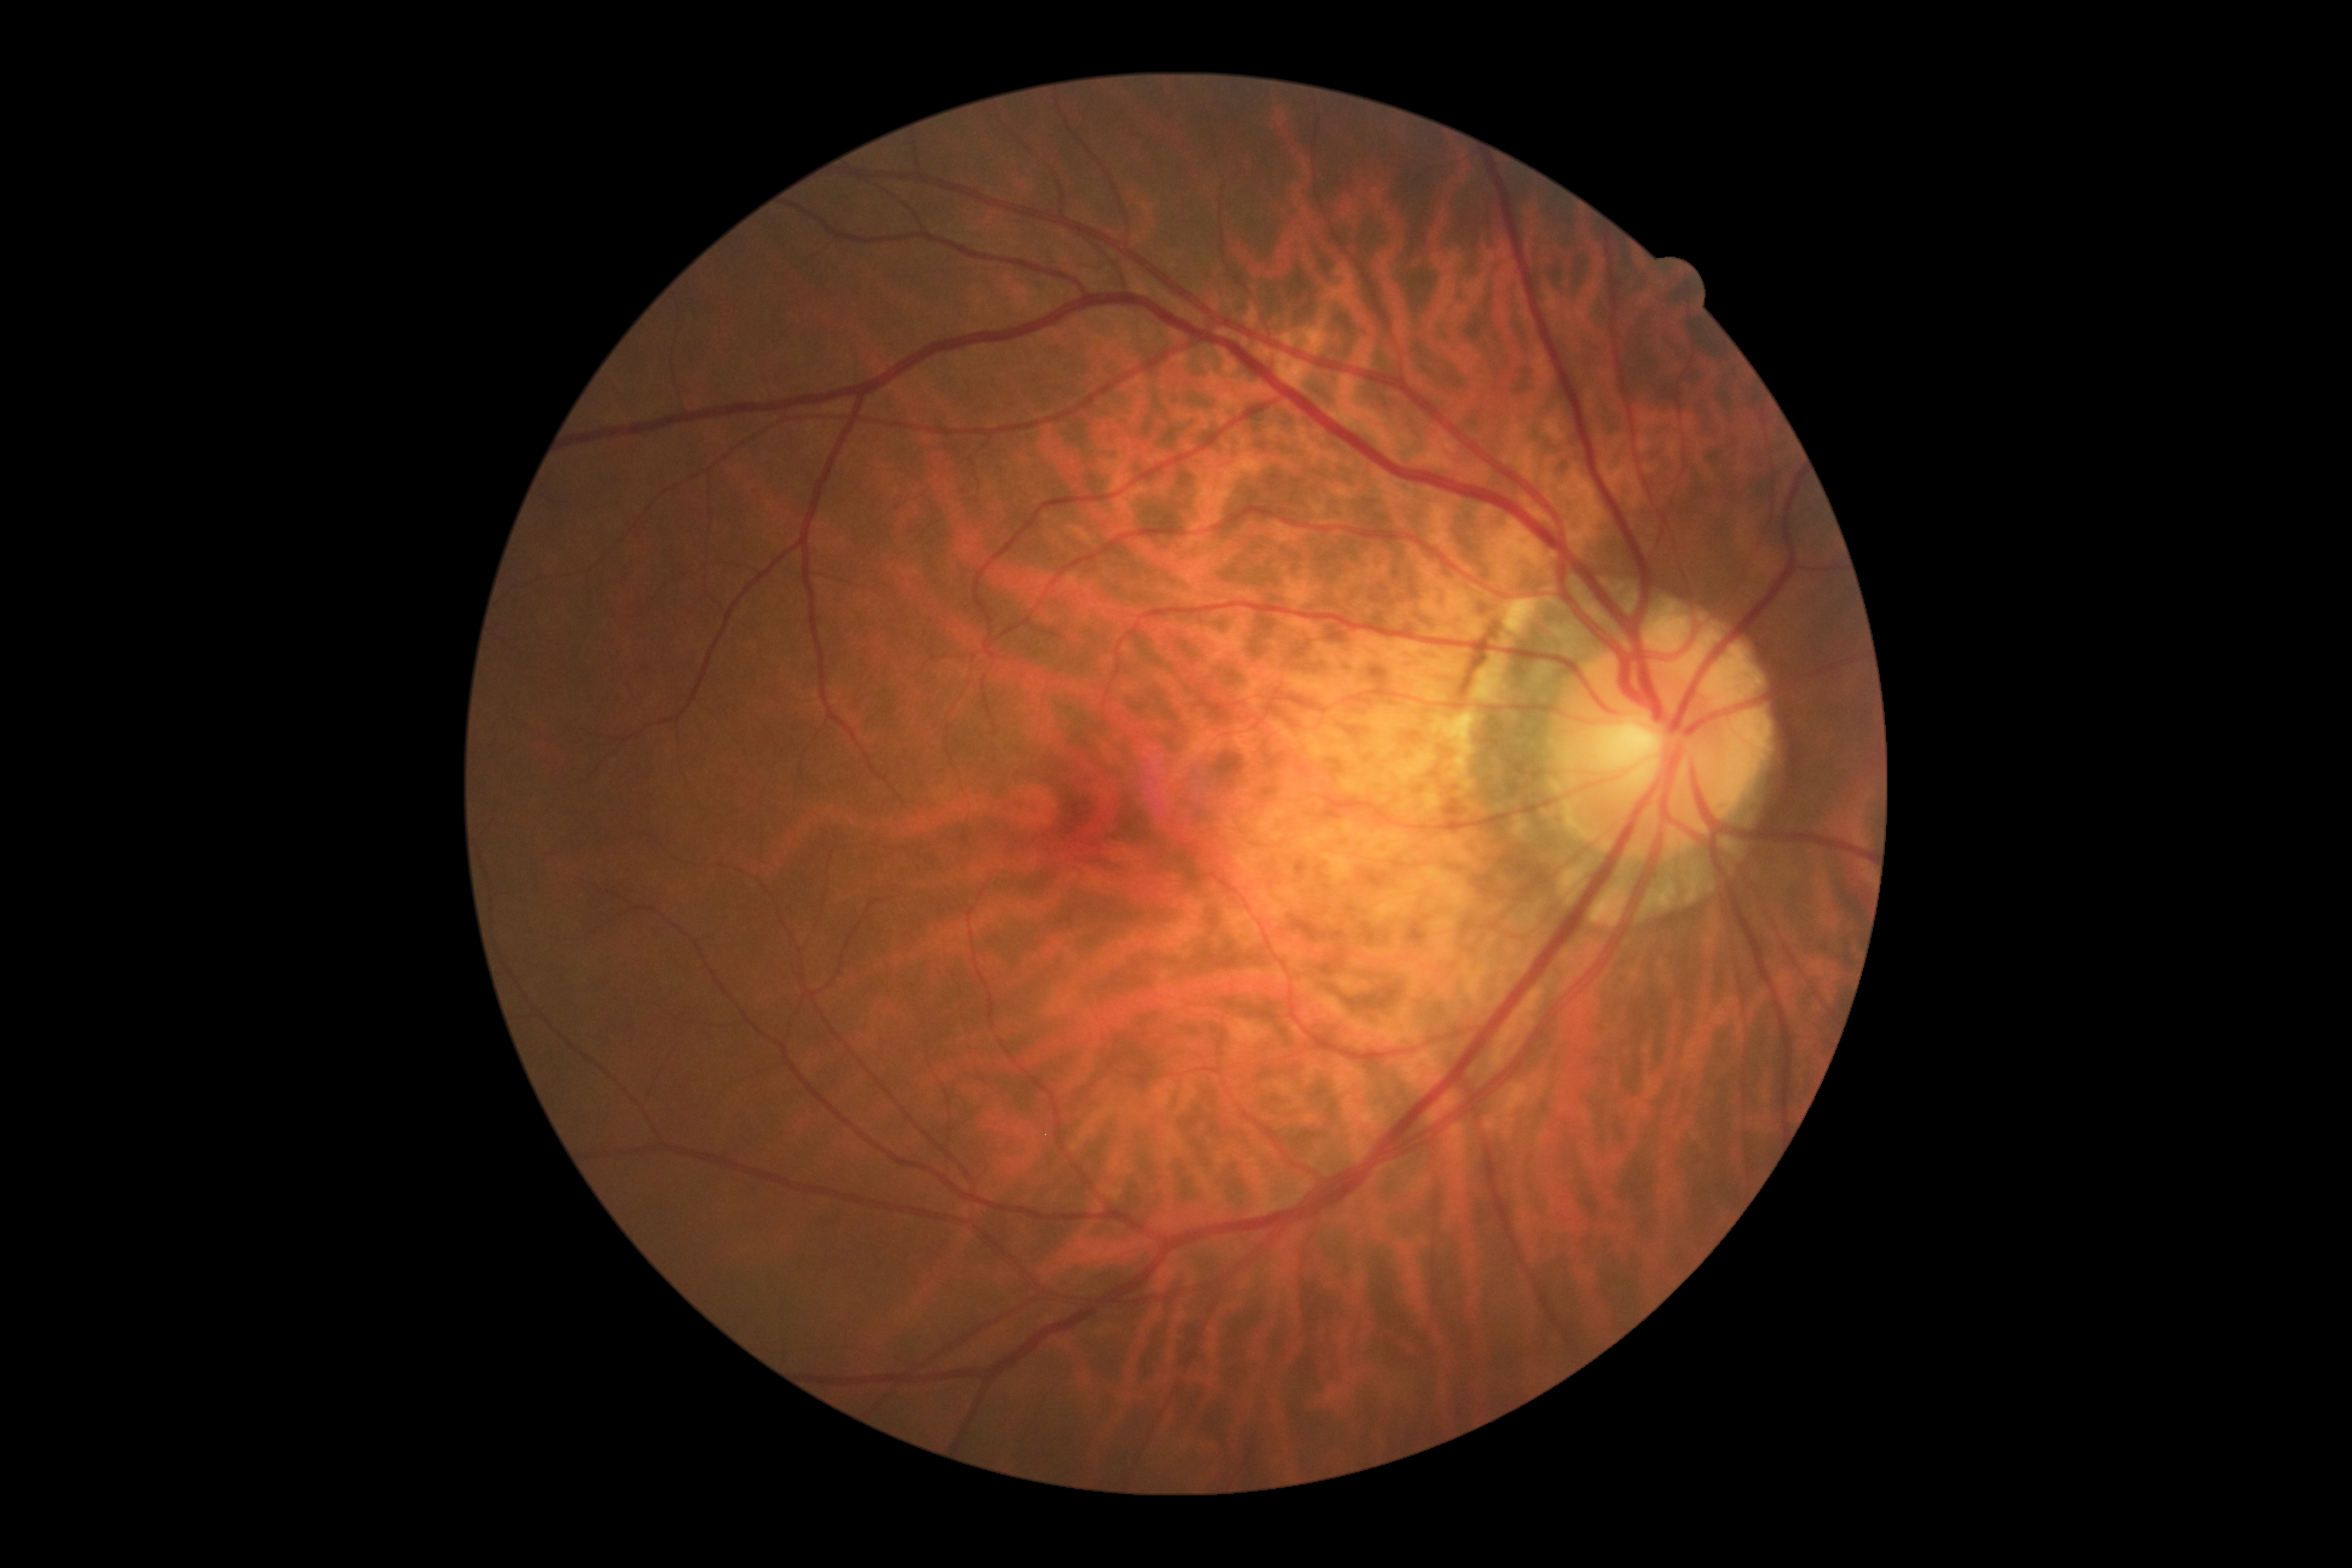 Diabetic retinopathy (DR) is no apparent retinopathy (grade 0).
No DR findings.